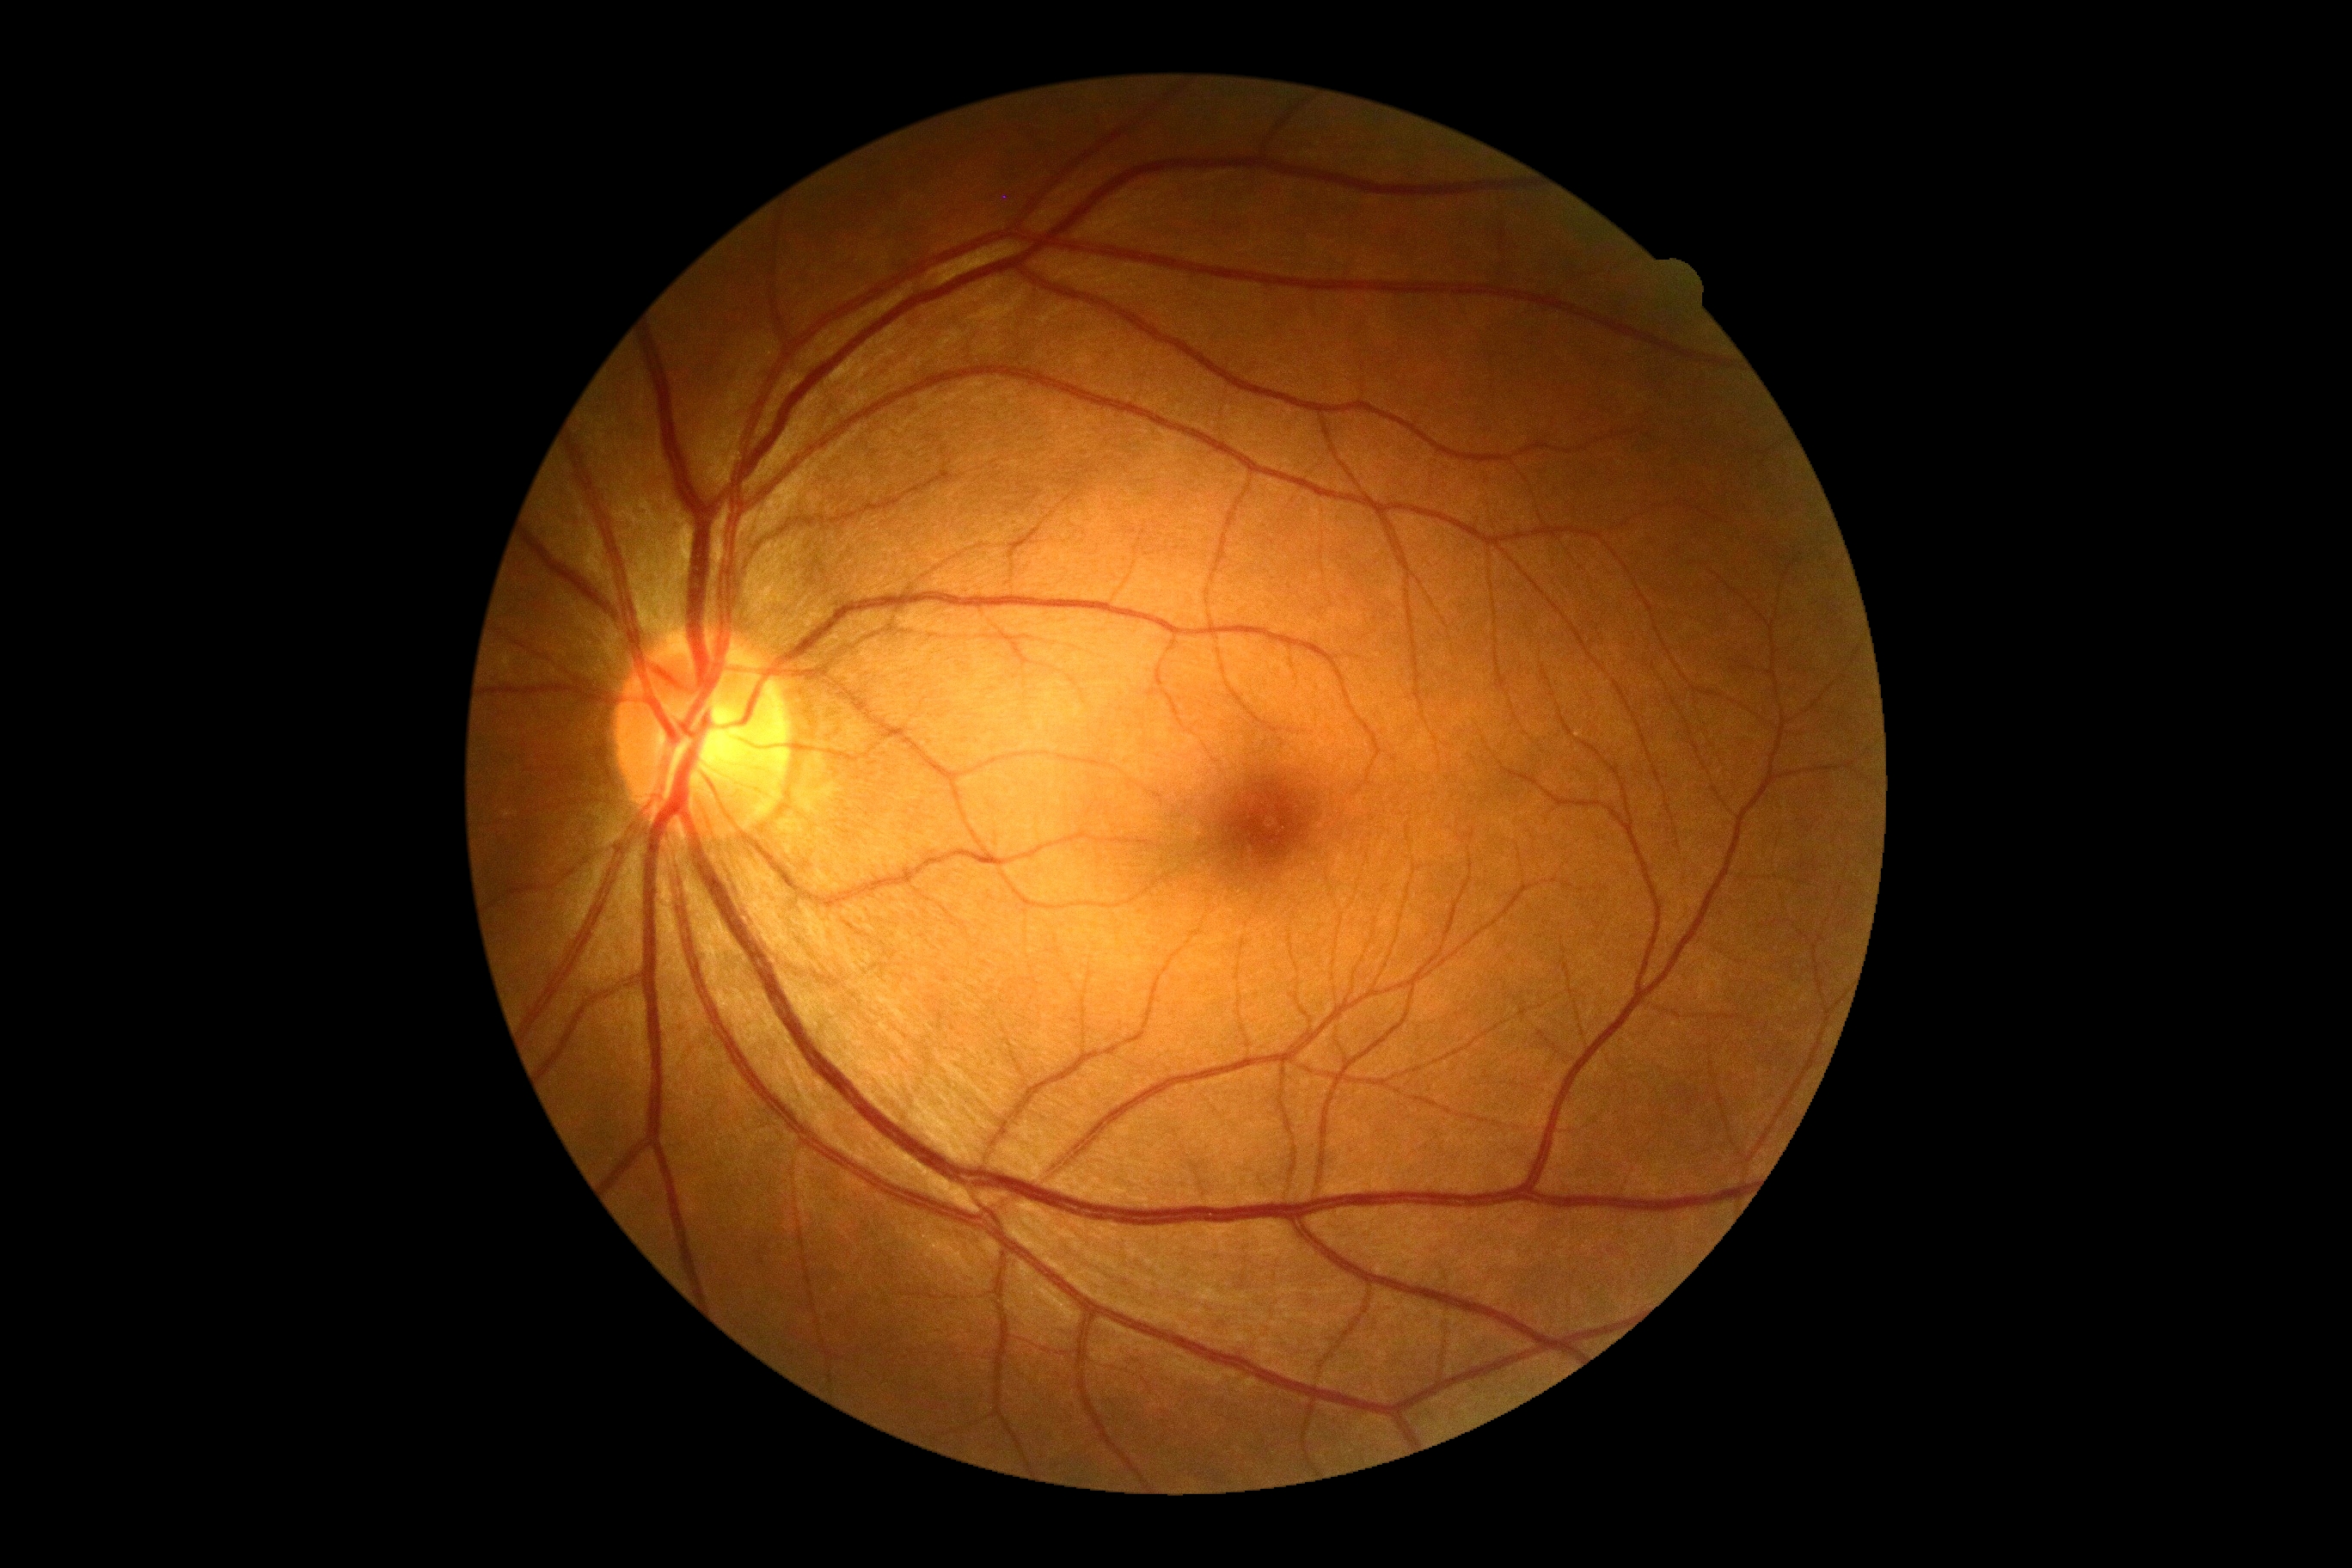

No diabetic retinal disease findings.
Diabetic retinopathy grade is 0 (no apparent retinopathy).